CFP, camera: NIDEK AFC-230, FOV: 45 degrees, no pharmacologic dilation: 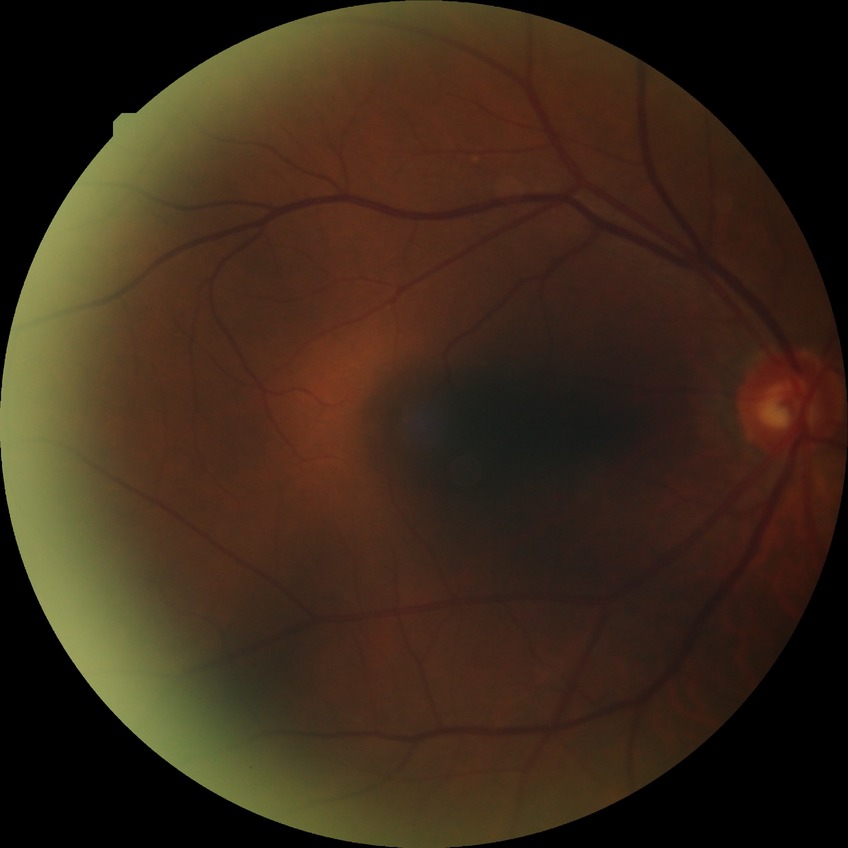

Davis grading is no diabetic retinopathy.